Optic disc-centered crop from a color fundus photograph
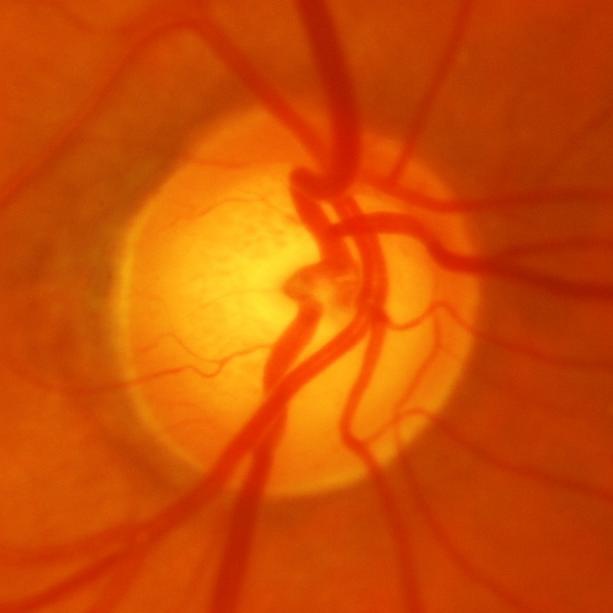
Showing glaucomatous findings.